2352x1568px, FOV: 45 degrees:
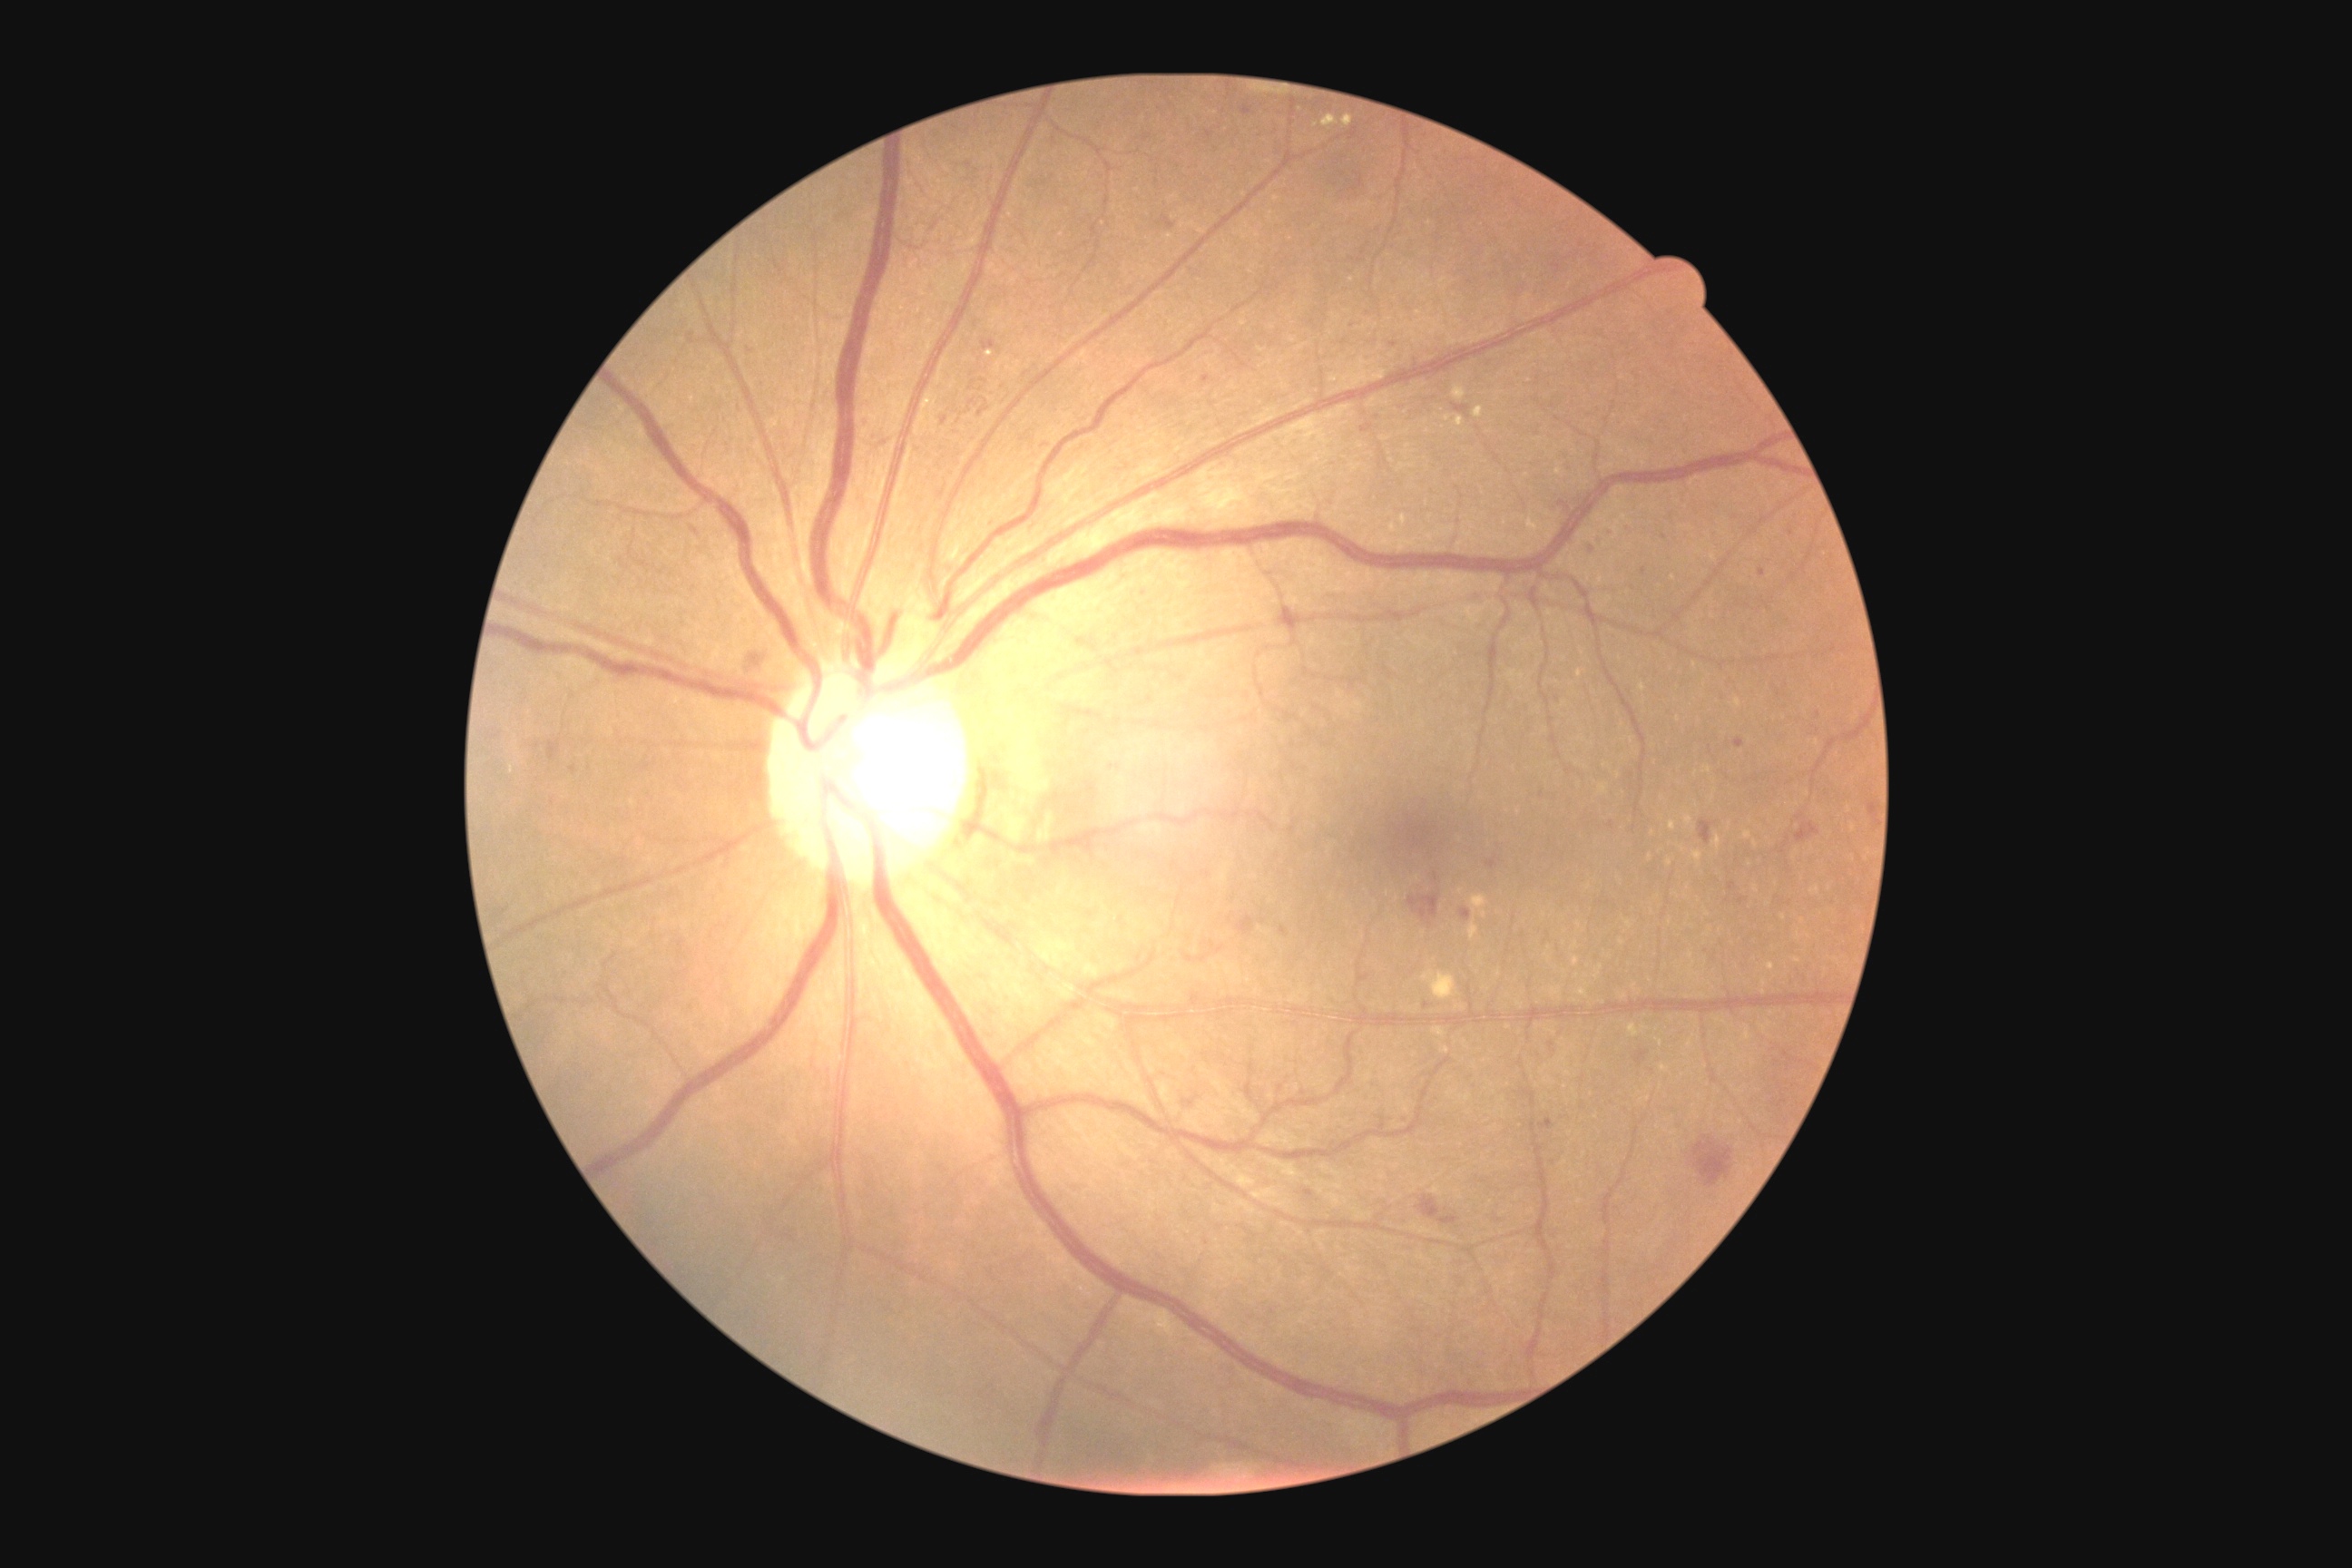 partial: true
dr_grade: 2
dr_grade_name: moderate NPDR
lesions:
  he:
    - x1=1625 y1=525 x2=1634 y2=533
    - x1=1280 y1=926 x2=1288 y2=936
    - x1=1157 y1=217 x2=1175 y2=231
    - x1=983 y1=340 x2=995 y2=351
    - x1=1729 y1=883 x2=1738 y2=892
    - x1=741 y1=651 x2=770 y2=676
    - x1=1868 y1=803 x2=1876 y2=818
    - x1=685 y1=522 x2=705 y2=544
    - x1=1776 y1=689 x2=1785 y2=700
    - x1=1740 y1=897 x2=1747 y2=905
    - x1=1553 y1=264 x2=1562 y2=270
    - x1=1634 y1=1052 x2=1649 y2=1066
    - x1=1487 y1=858 x2=1498 y2=868
  he_small:
    - 1551/1045
    - 1309/1194
    - 1846/930
    - 1670/314
    - 1144/594
    - 1394/345
    - 552/802